Acquired with a Topcon TRC, color fundus photograph centered on the optic disc:
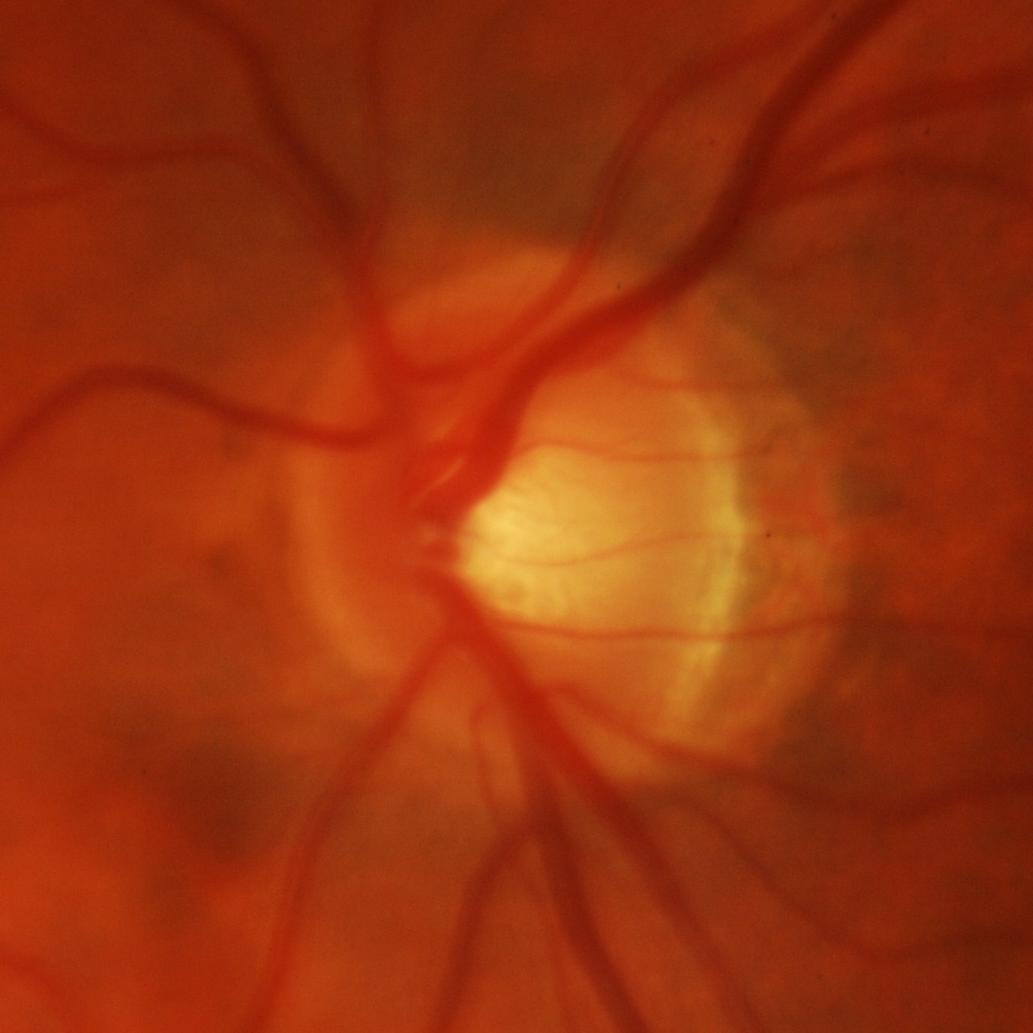 Consistent with glaucomatous damage to the optic nerve.